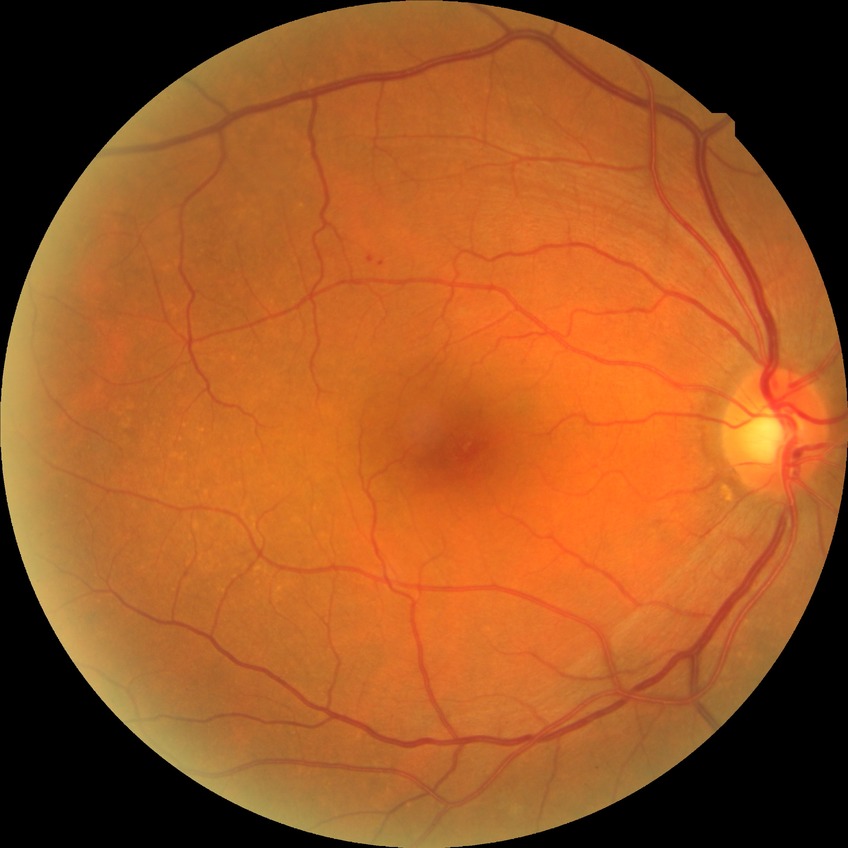

Diabetic retinopathy (DR) is NDR (no diabetic retinopathy).